DR severity per modified Davis staging — 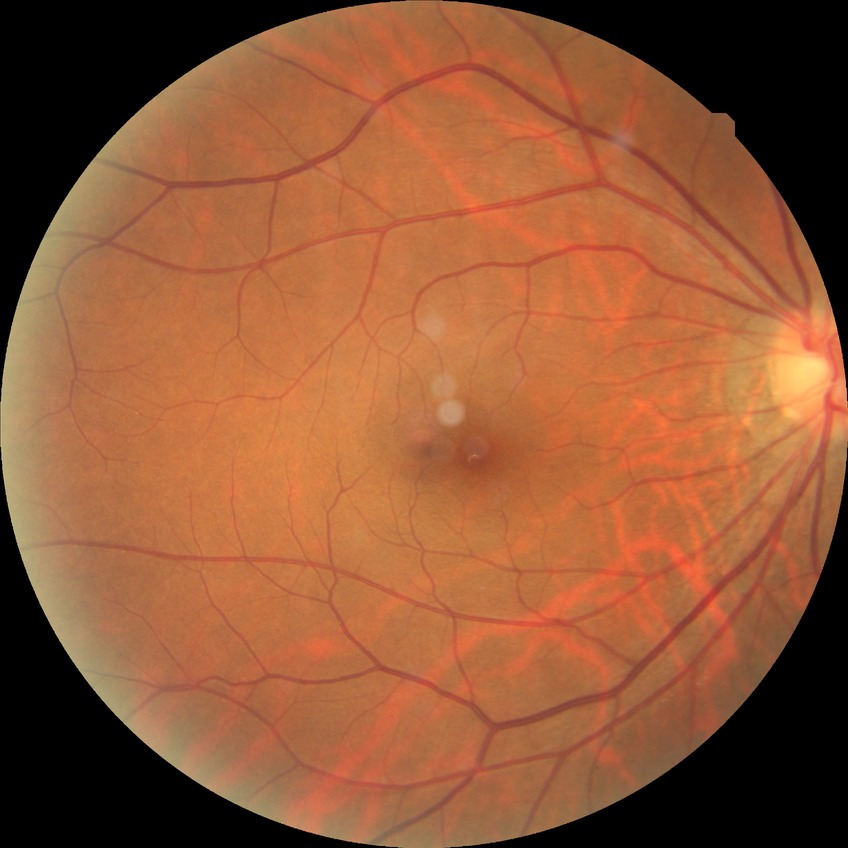
Diabetic retinopathy grade: no diabetic retinopathy.